2352 by 1568 pixels
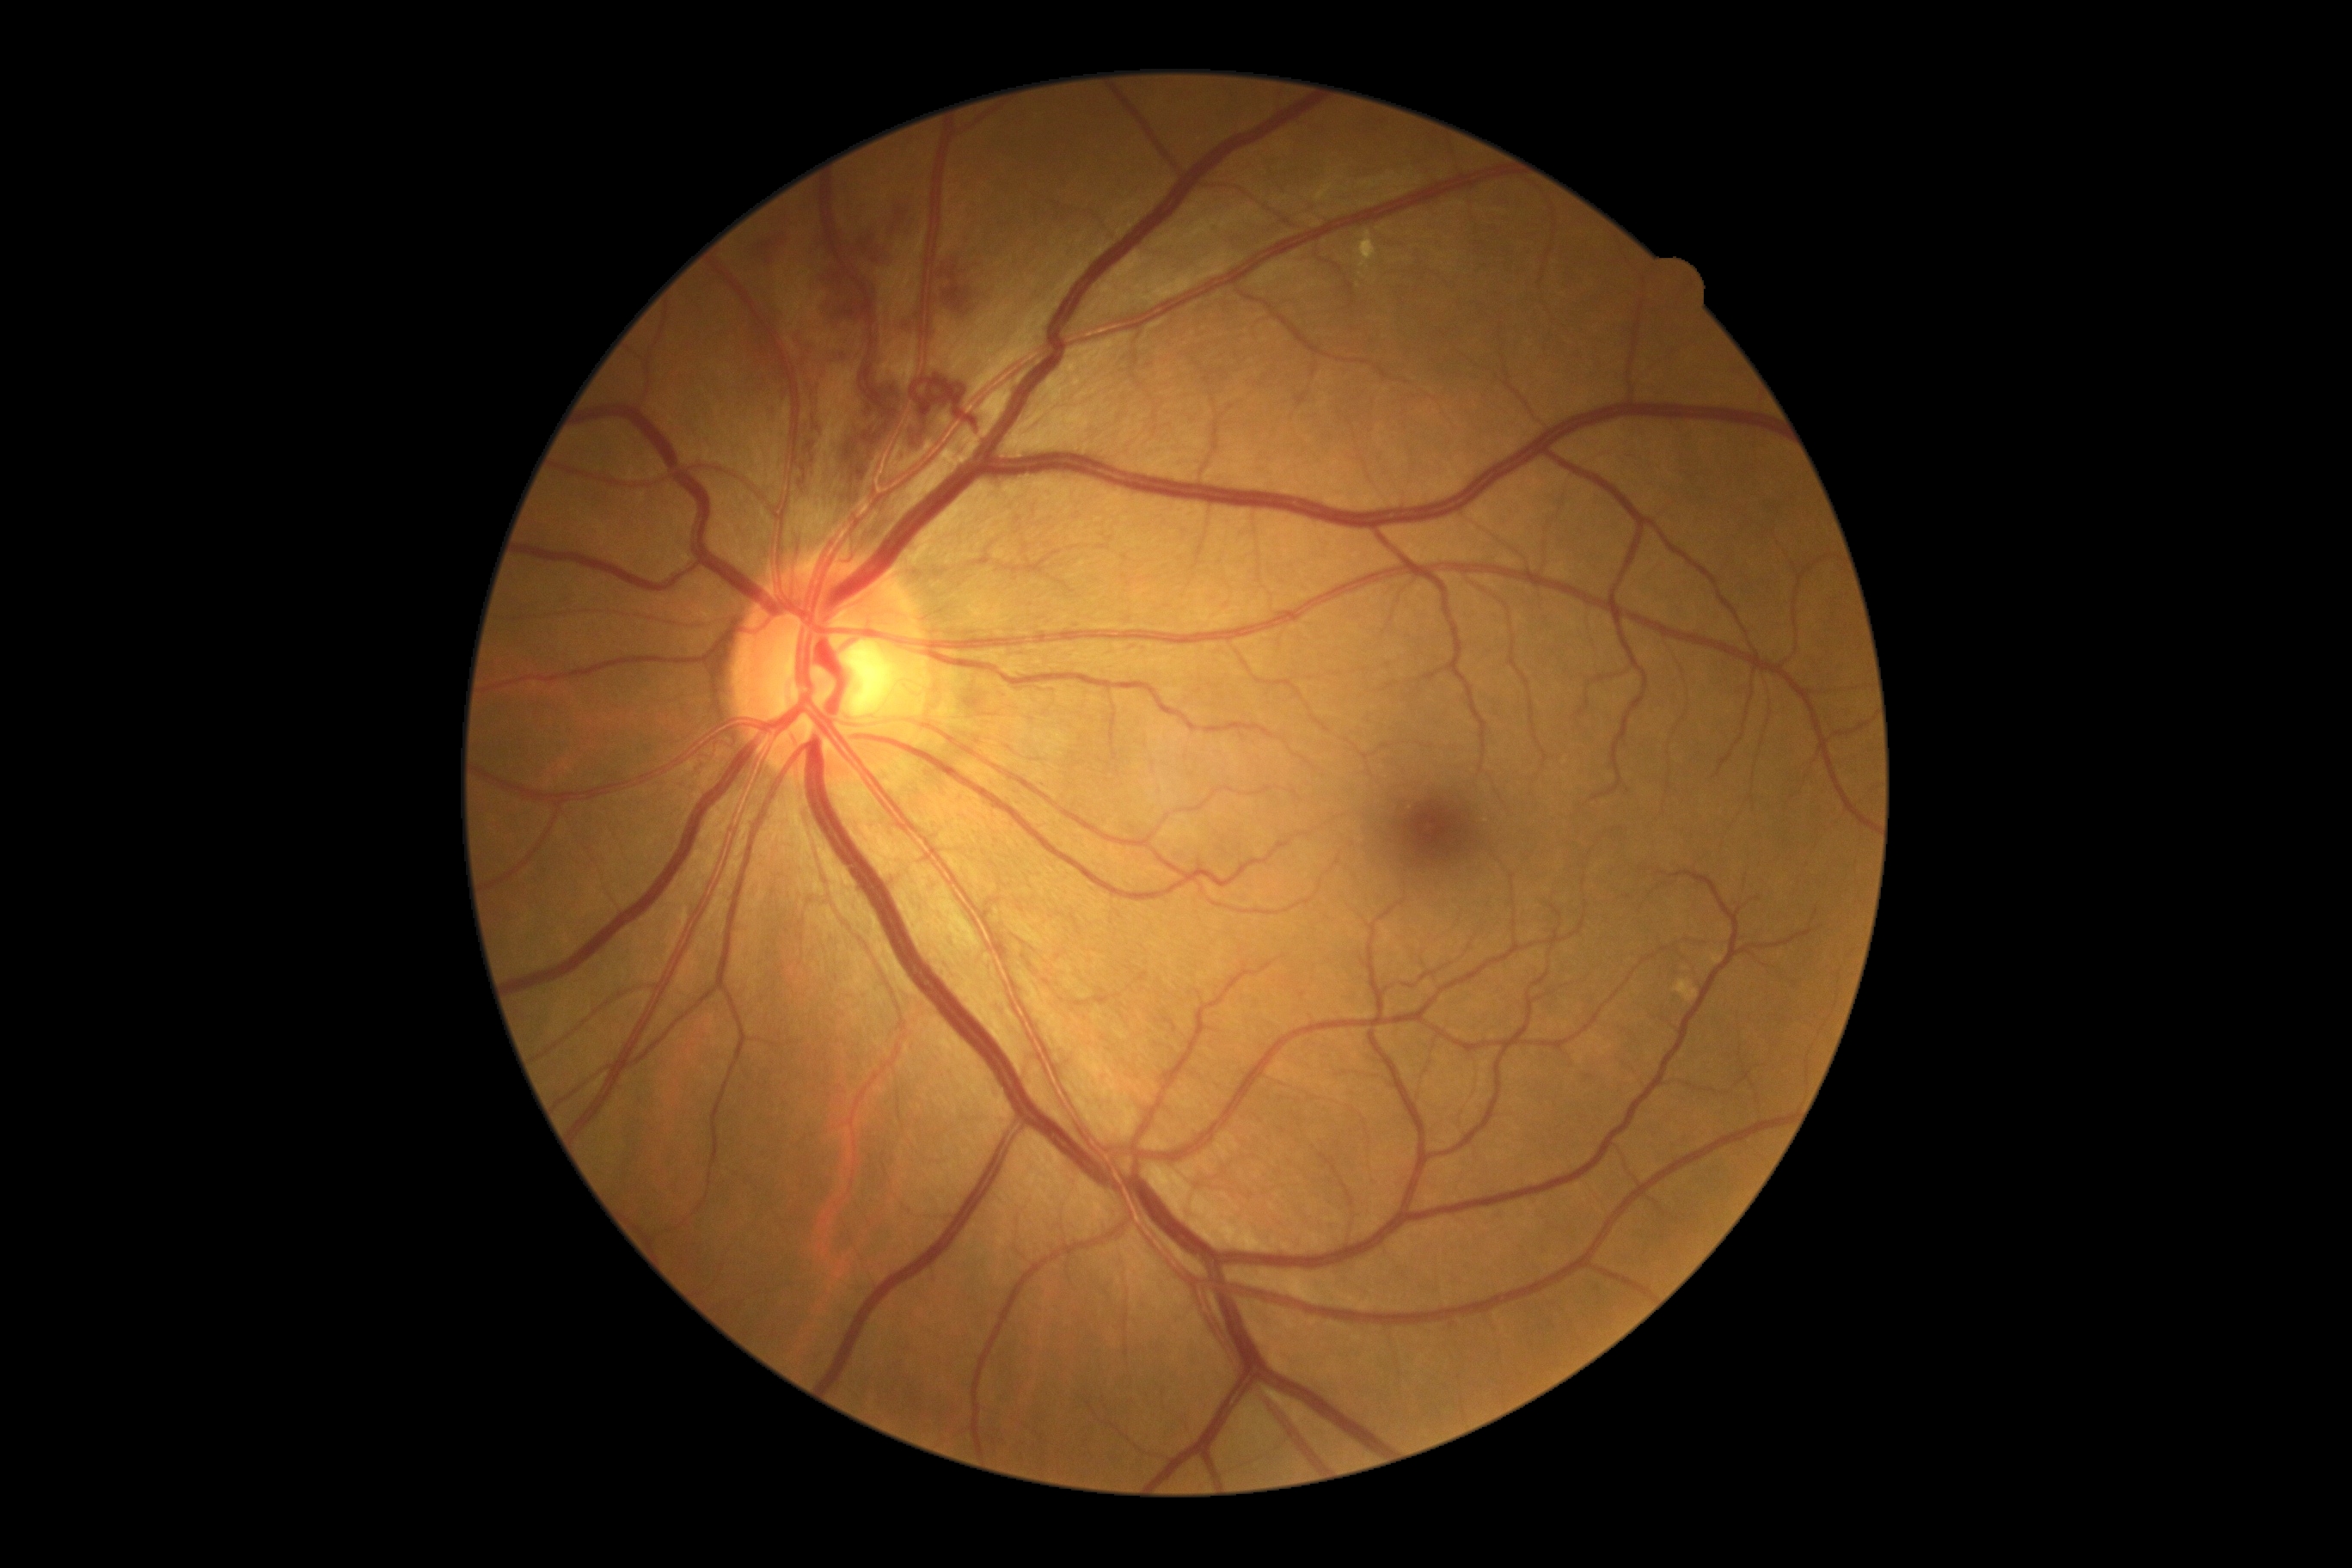 Diabetic retinopathy grade is 2; non-proliferative diabetic retinopathy
Lesions identified (partial list):
hard exudates (partial) = [left=1359, top=231, right=1378, bottom=269]
Small hard exudates approximately at <point>1361, 276</point>
hemorrhages = [left=905, top=307, right=917, bottom=334] | [left=852, top=429, right=883, bottom=482] | [left=938, top=252, right=960, bottom=276] | [left=845, top=448, right=855, bottom=460] | [left=945, top=267, right=972, bottom=317] | [left=752, top=236, right=785, bottom=264] | [left=861, top=223, right=893, bottom=260] | [left=747, top=319, right=769, bottom=357] | [left=848, top=424, right=861, bottom=444] | [left=890, top=193, right=917, bottom=235] | [left=830, top=341, right=857, bottom=365] | [left=818, top=267, right=862, bottom=319]
soft exudates = not present
microaneurysms = not present